Wide-field fundus image from infant ROP screening.
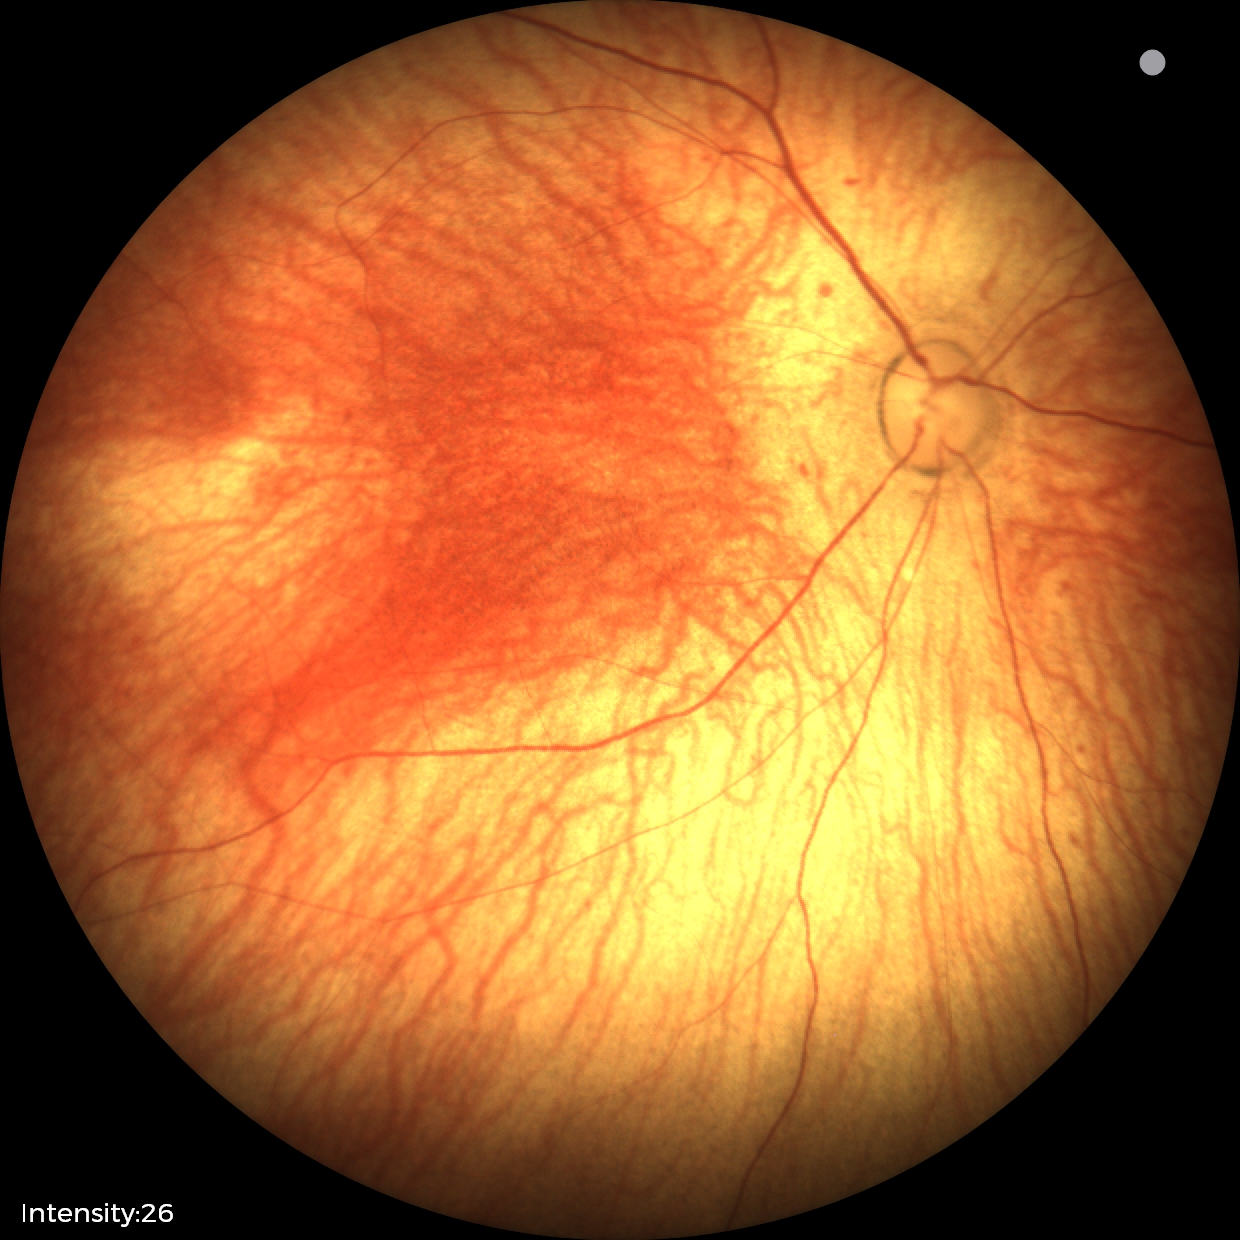

Screening examination diagnosed as physiological.